Color fundus photograph; no pharmacologic dilation; 45-degree field of view.
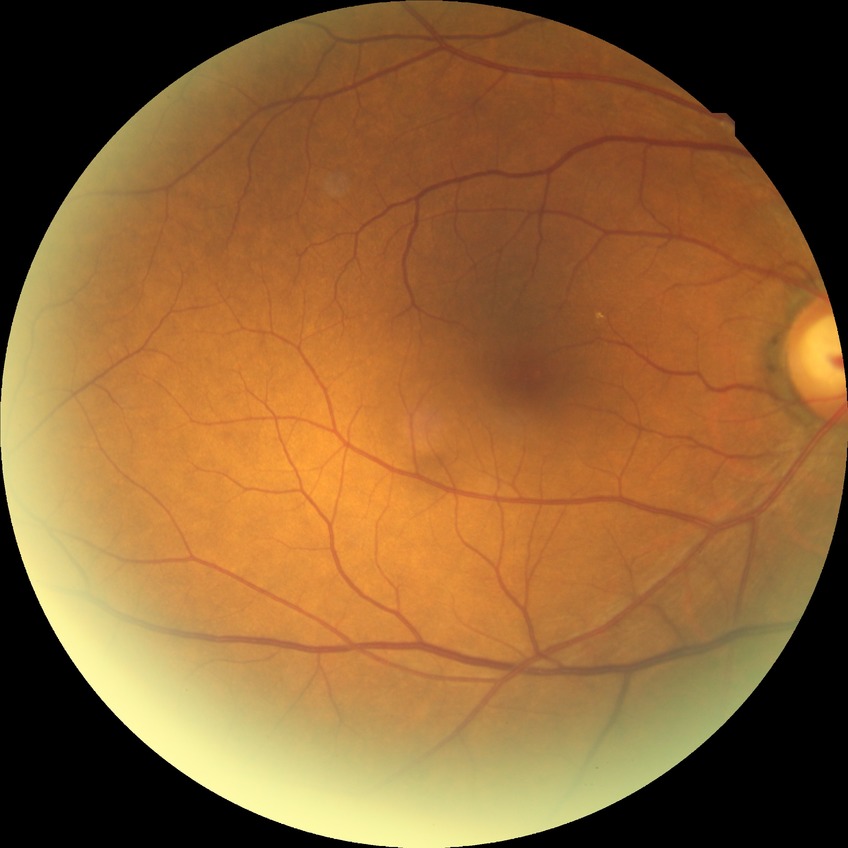
modified Davis classification: no diabetic retinopathy.